45° field of view · retinal fundus photograph · 2352 x 1568 pixels: 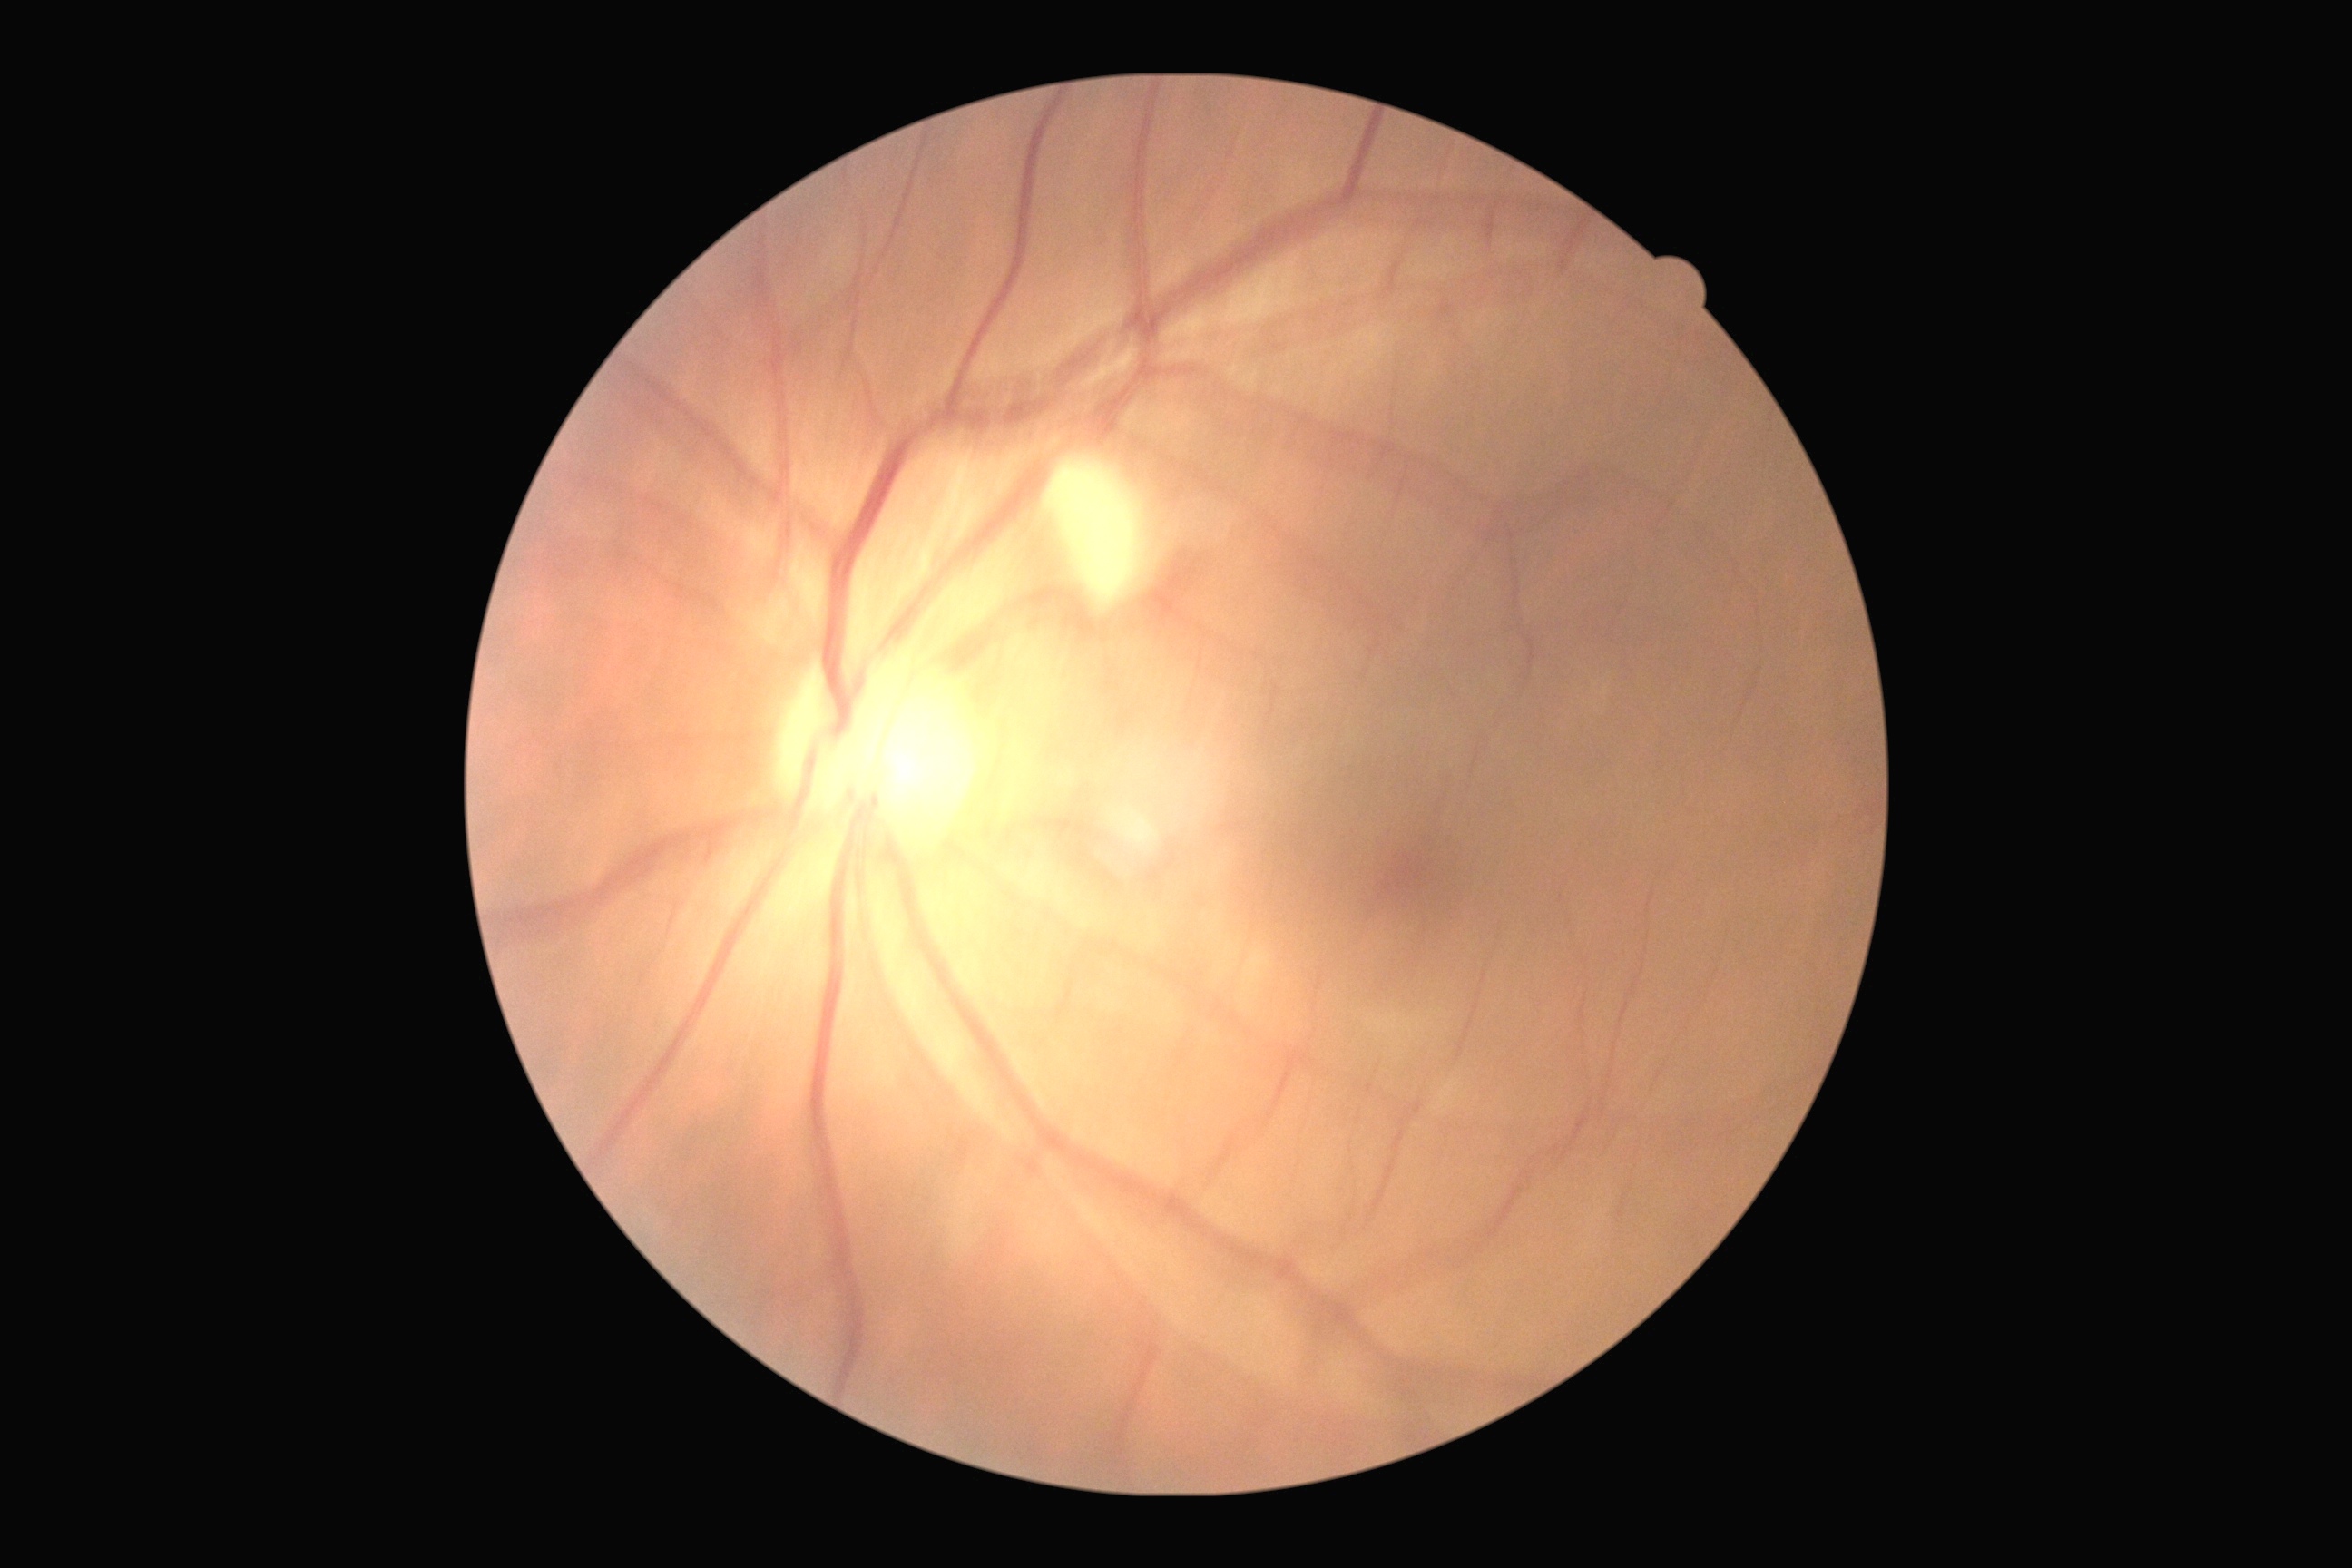 Diabetic retinopathy grade is moderate NPDR (2).